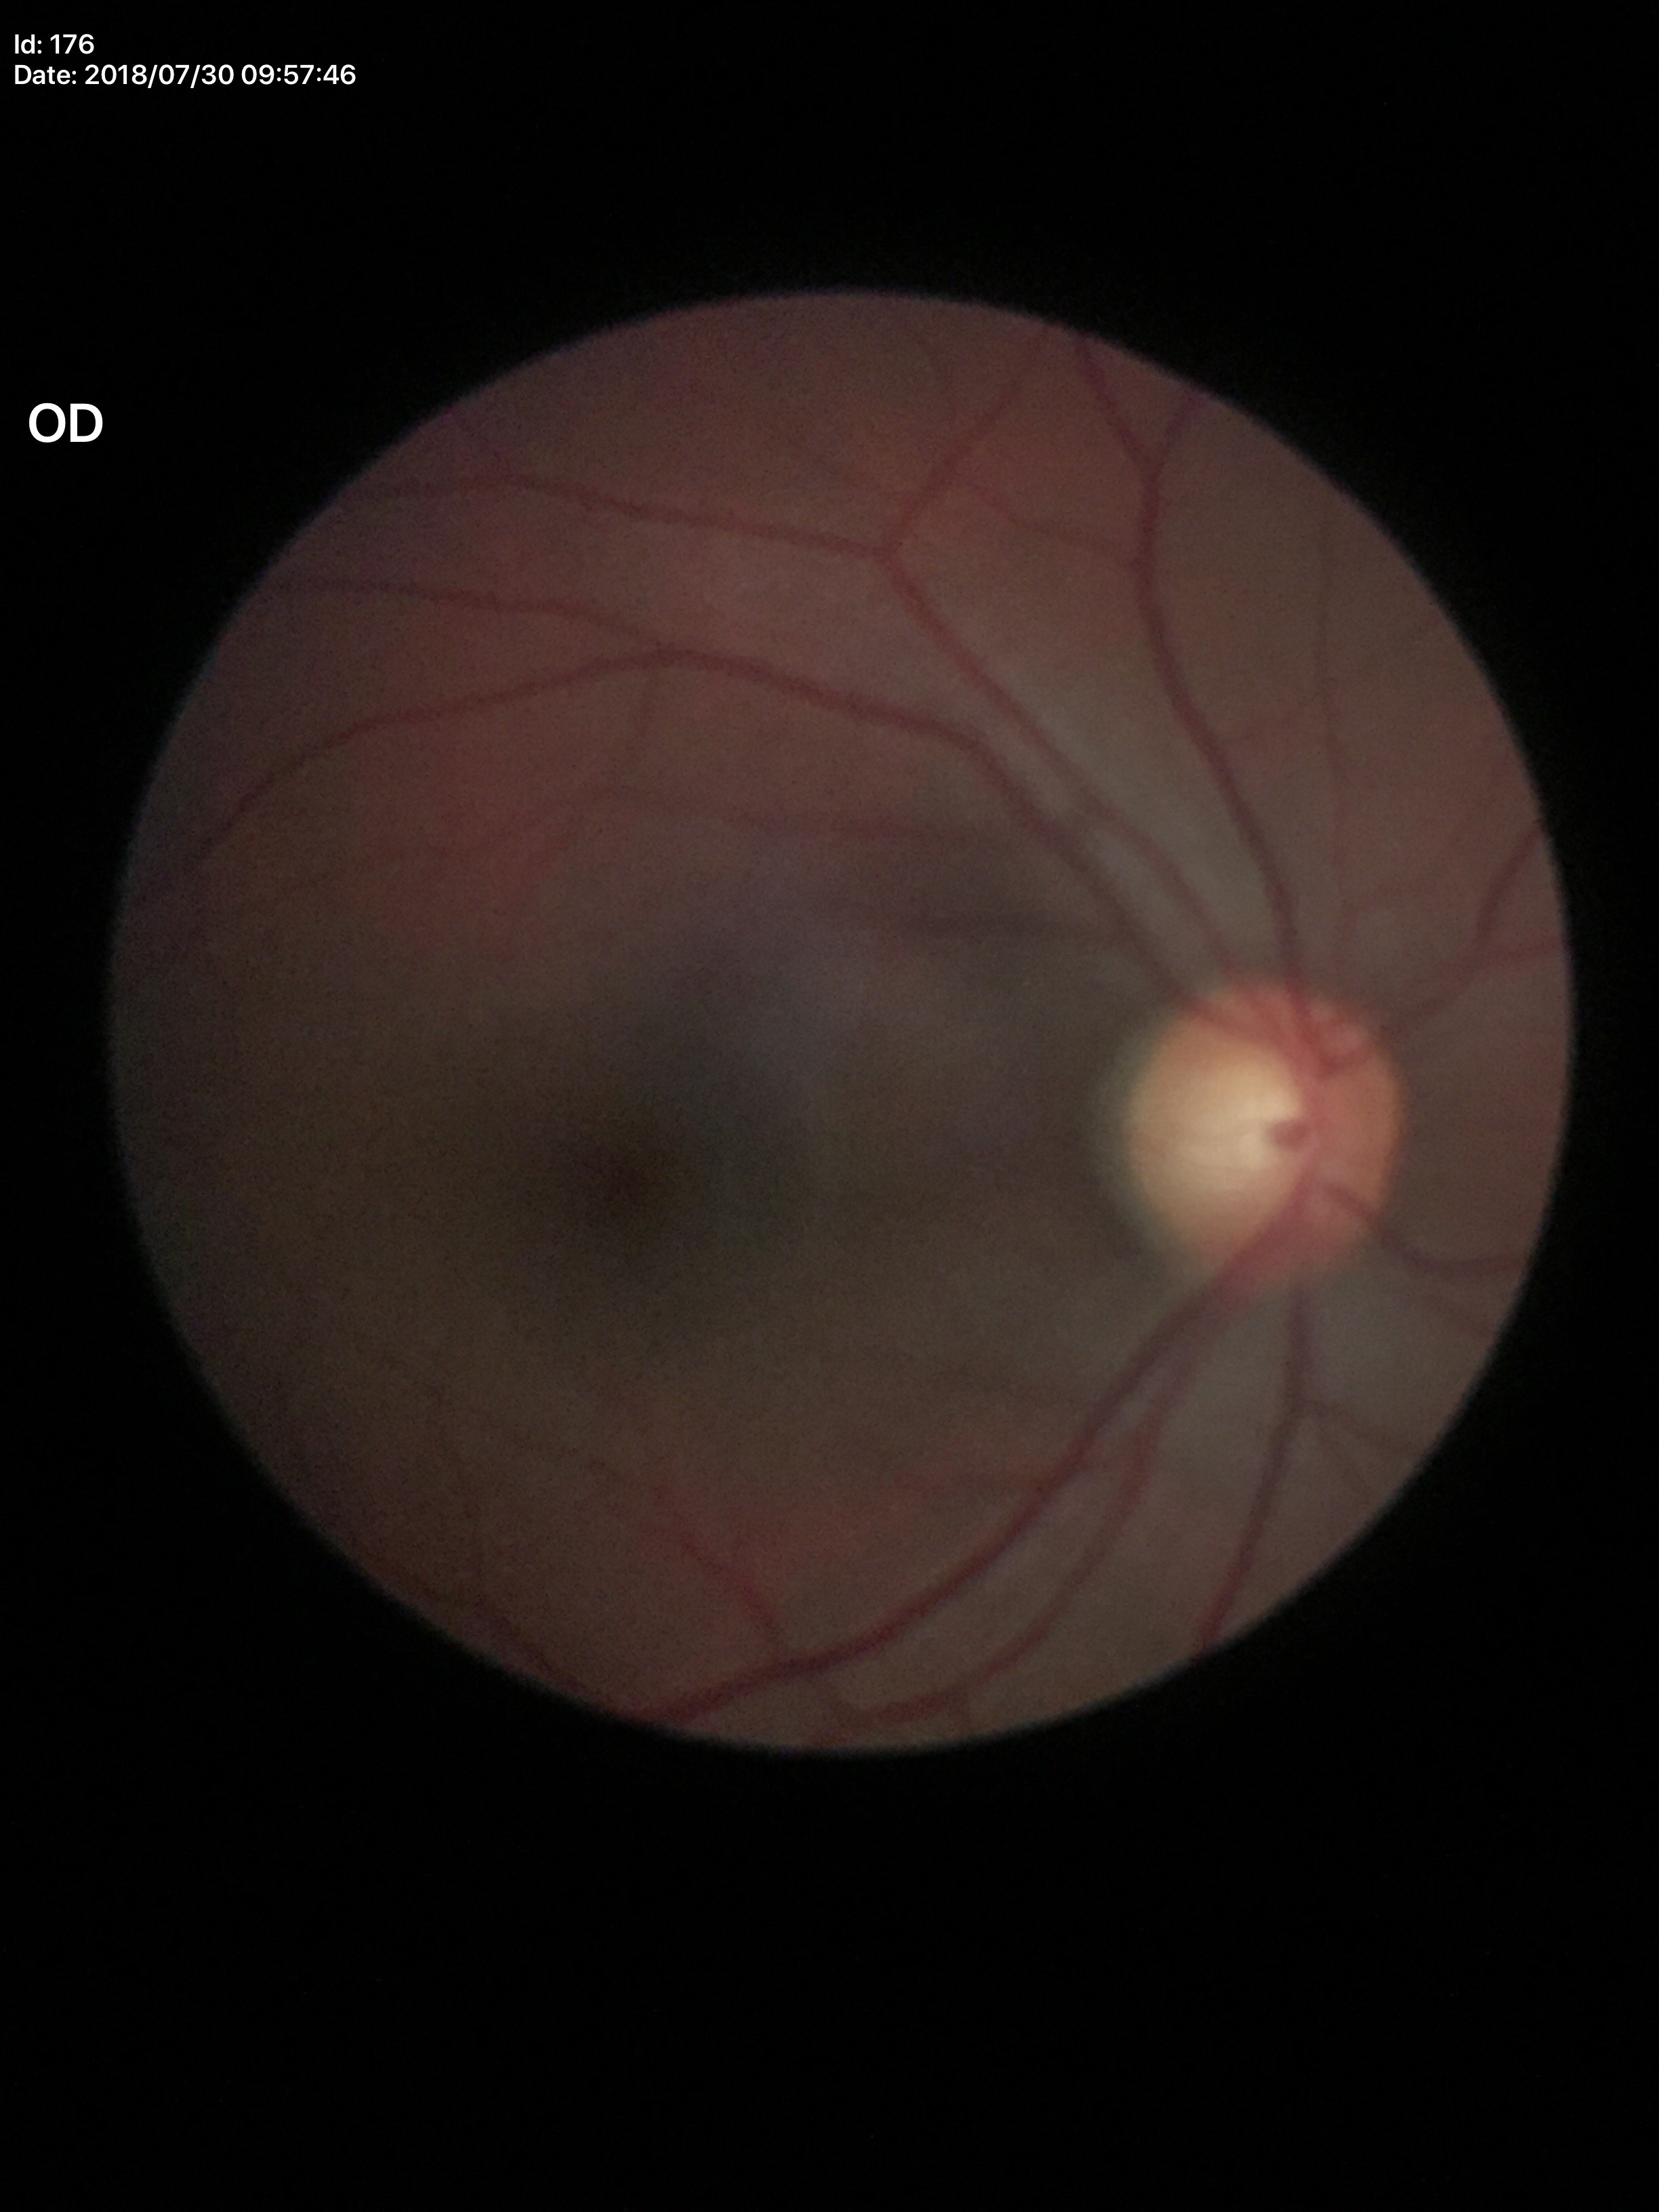

Annotations:
* Glaucoma assessment — suspect
* area cup-disc ratio — 0.38
* horizontal cup-to-disc ratio — 0.60
* vertical C/D ratio — 0.62